Color fundus image
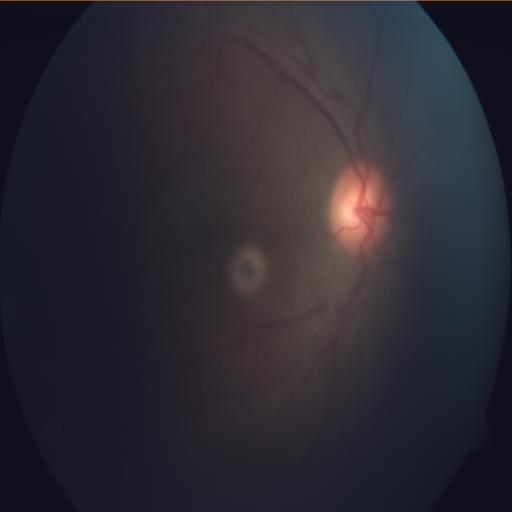 Diagnosis: optic disc cupping (ODC).